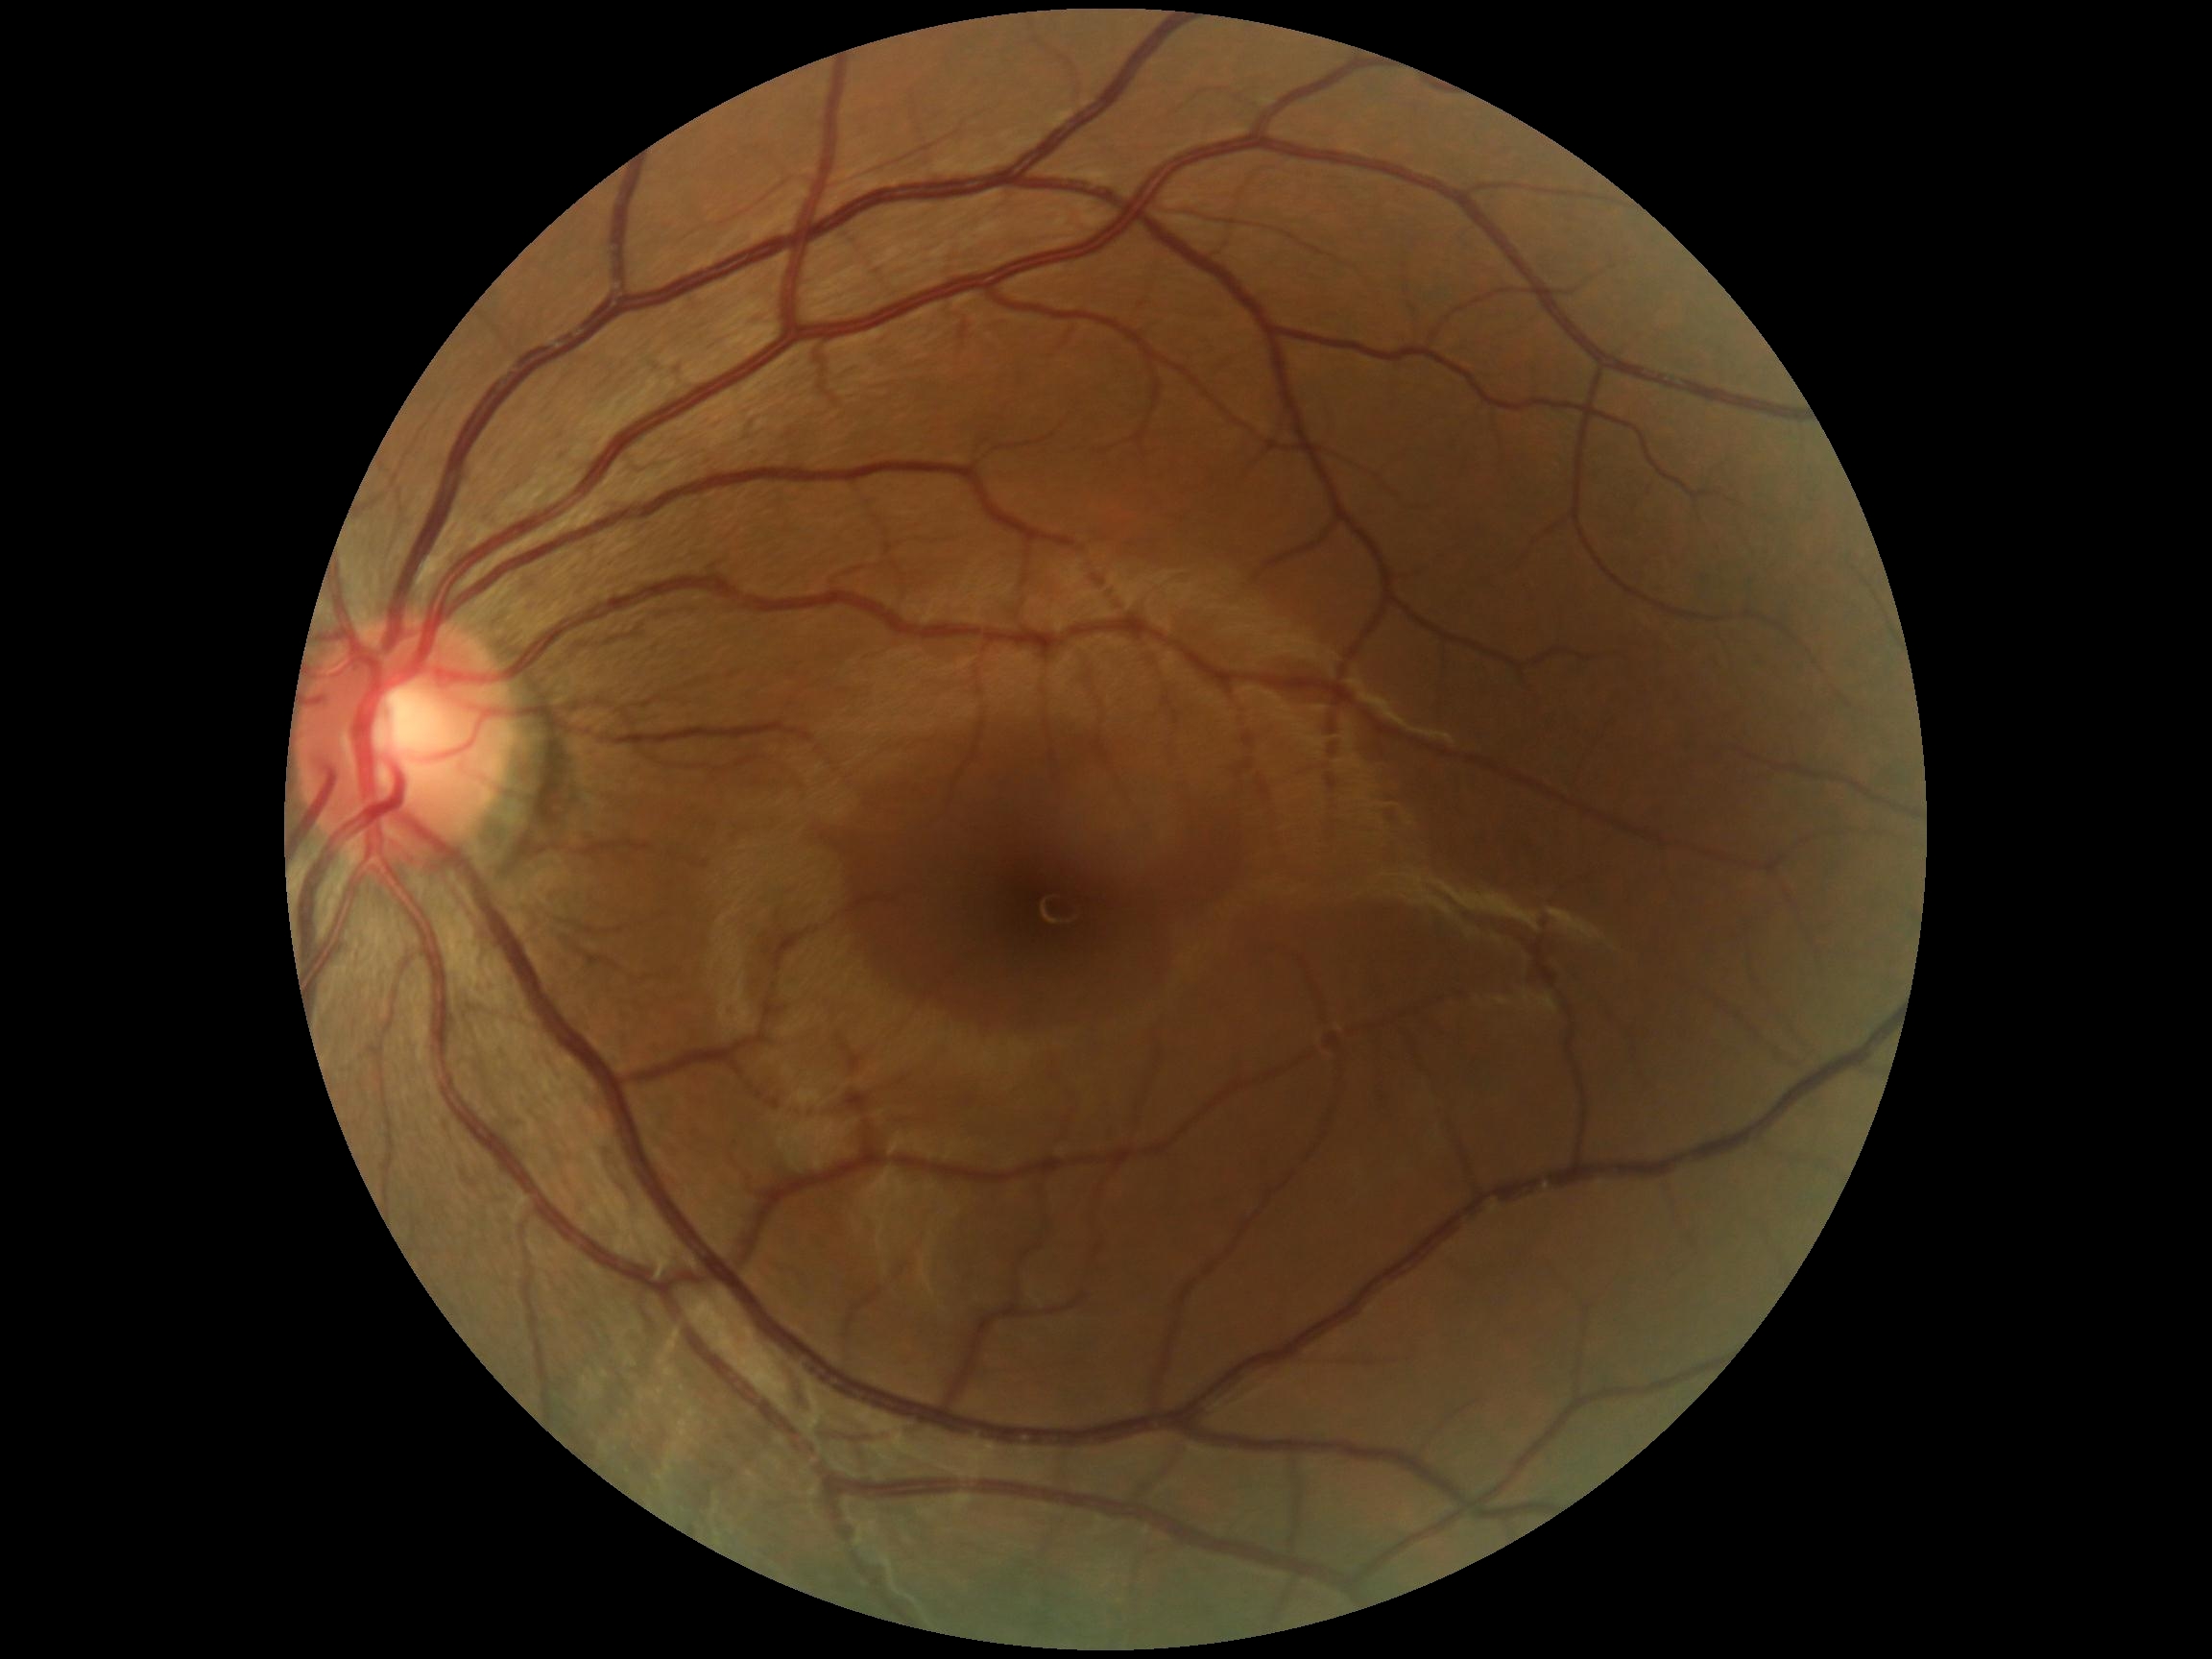
  dr_impression: negative for DR
  dr_grade: grade 0 (no apparent retinopathy)